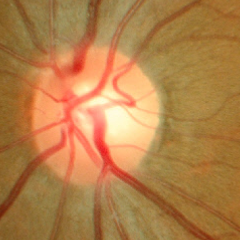

No glaucomatous optic neuropathy.